FOV: 45 degrees · modified Davis classification · posterior pole color fundus photograph.
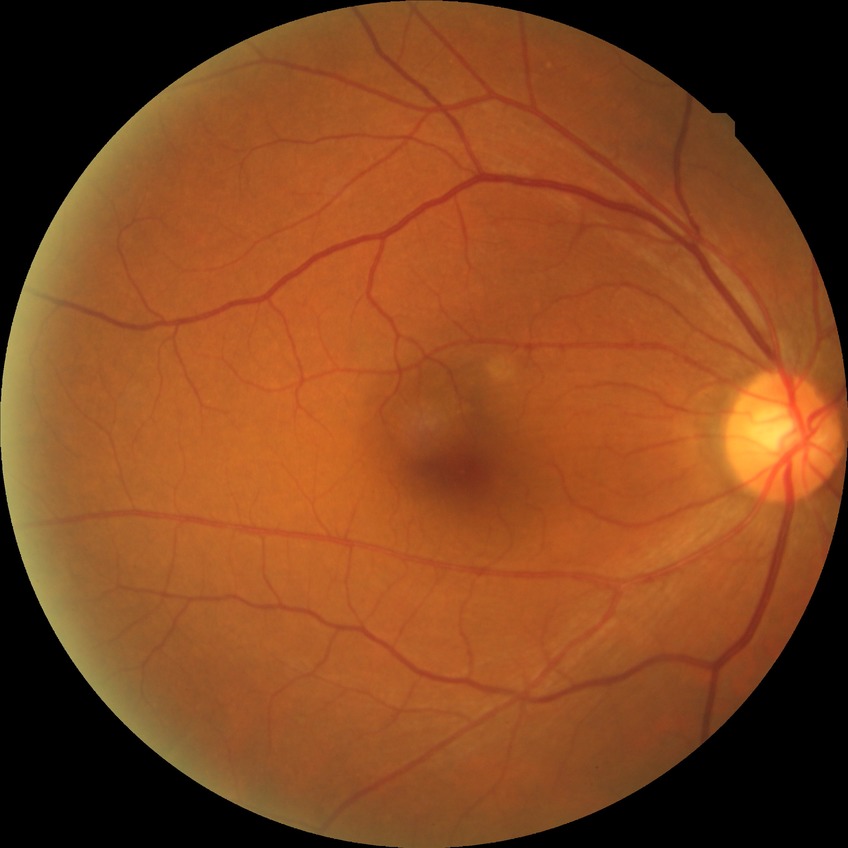

Diabetic retinopathy severity is no diabetic retinopathy.